Camera: Clarity RetCam 3 (130° FOV) · wide-field contact fundus photograph of an infant: 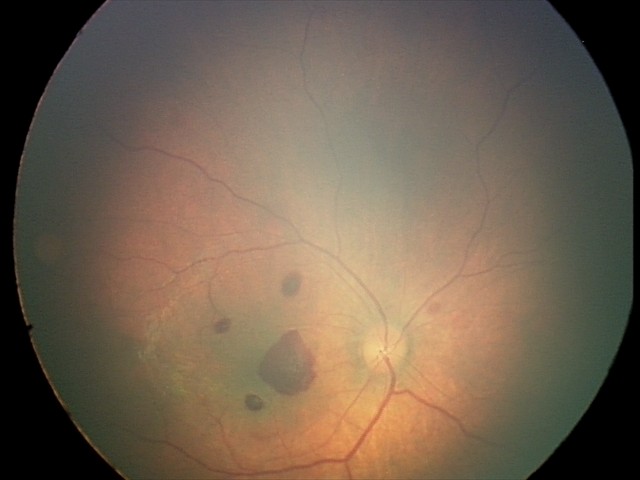

Series diagnosed as retinal hemorrhages.